Image size 2212x1659 · fundus photo · 45° field of view — 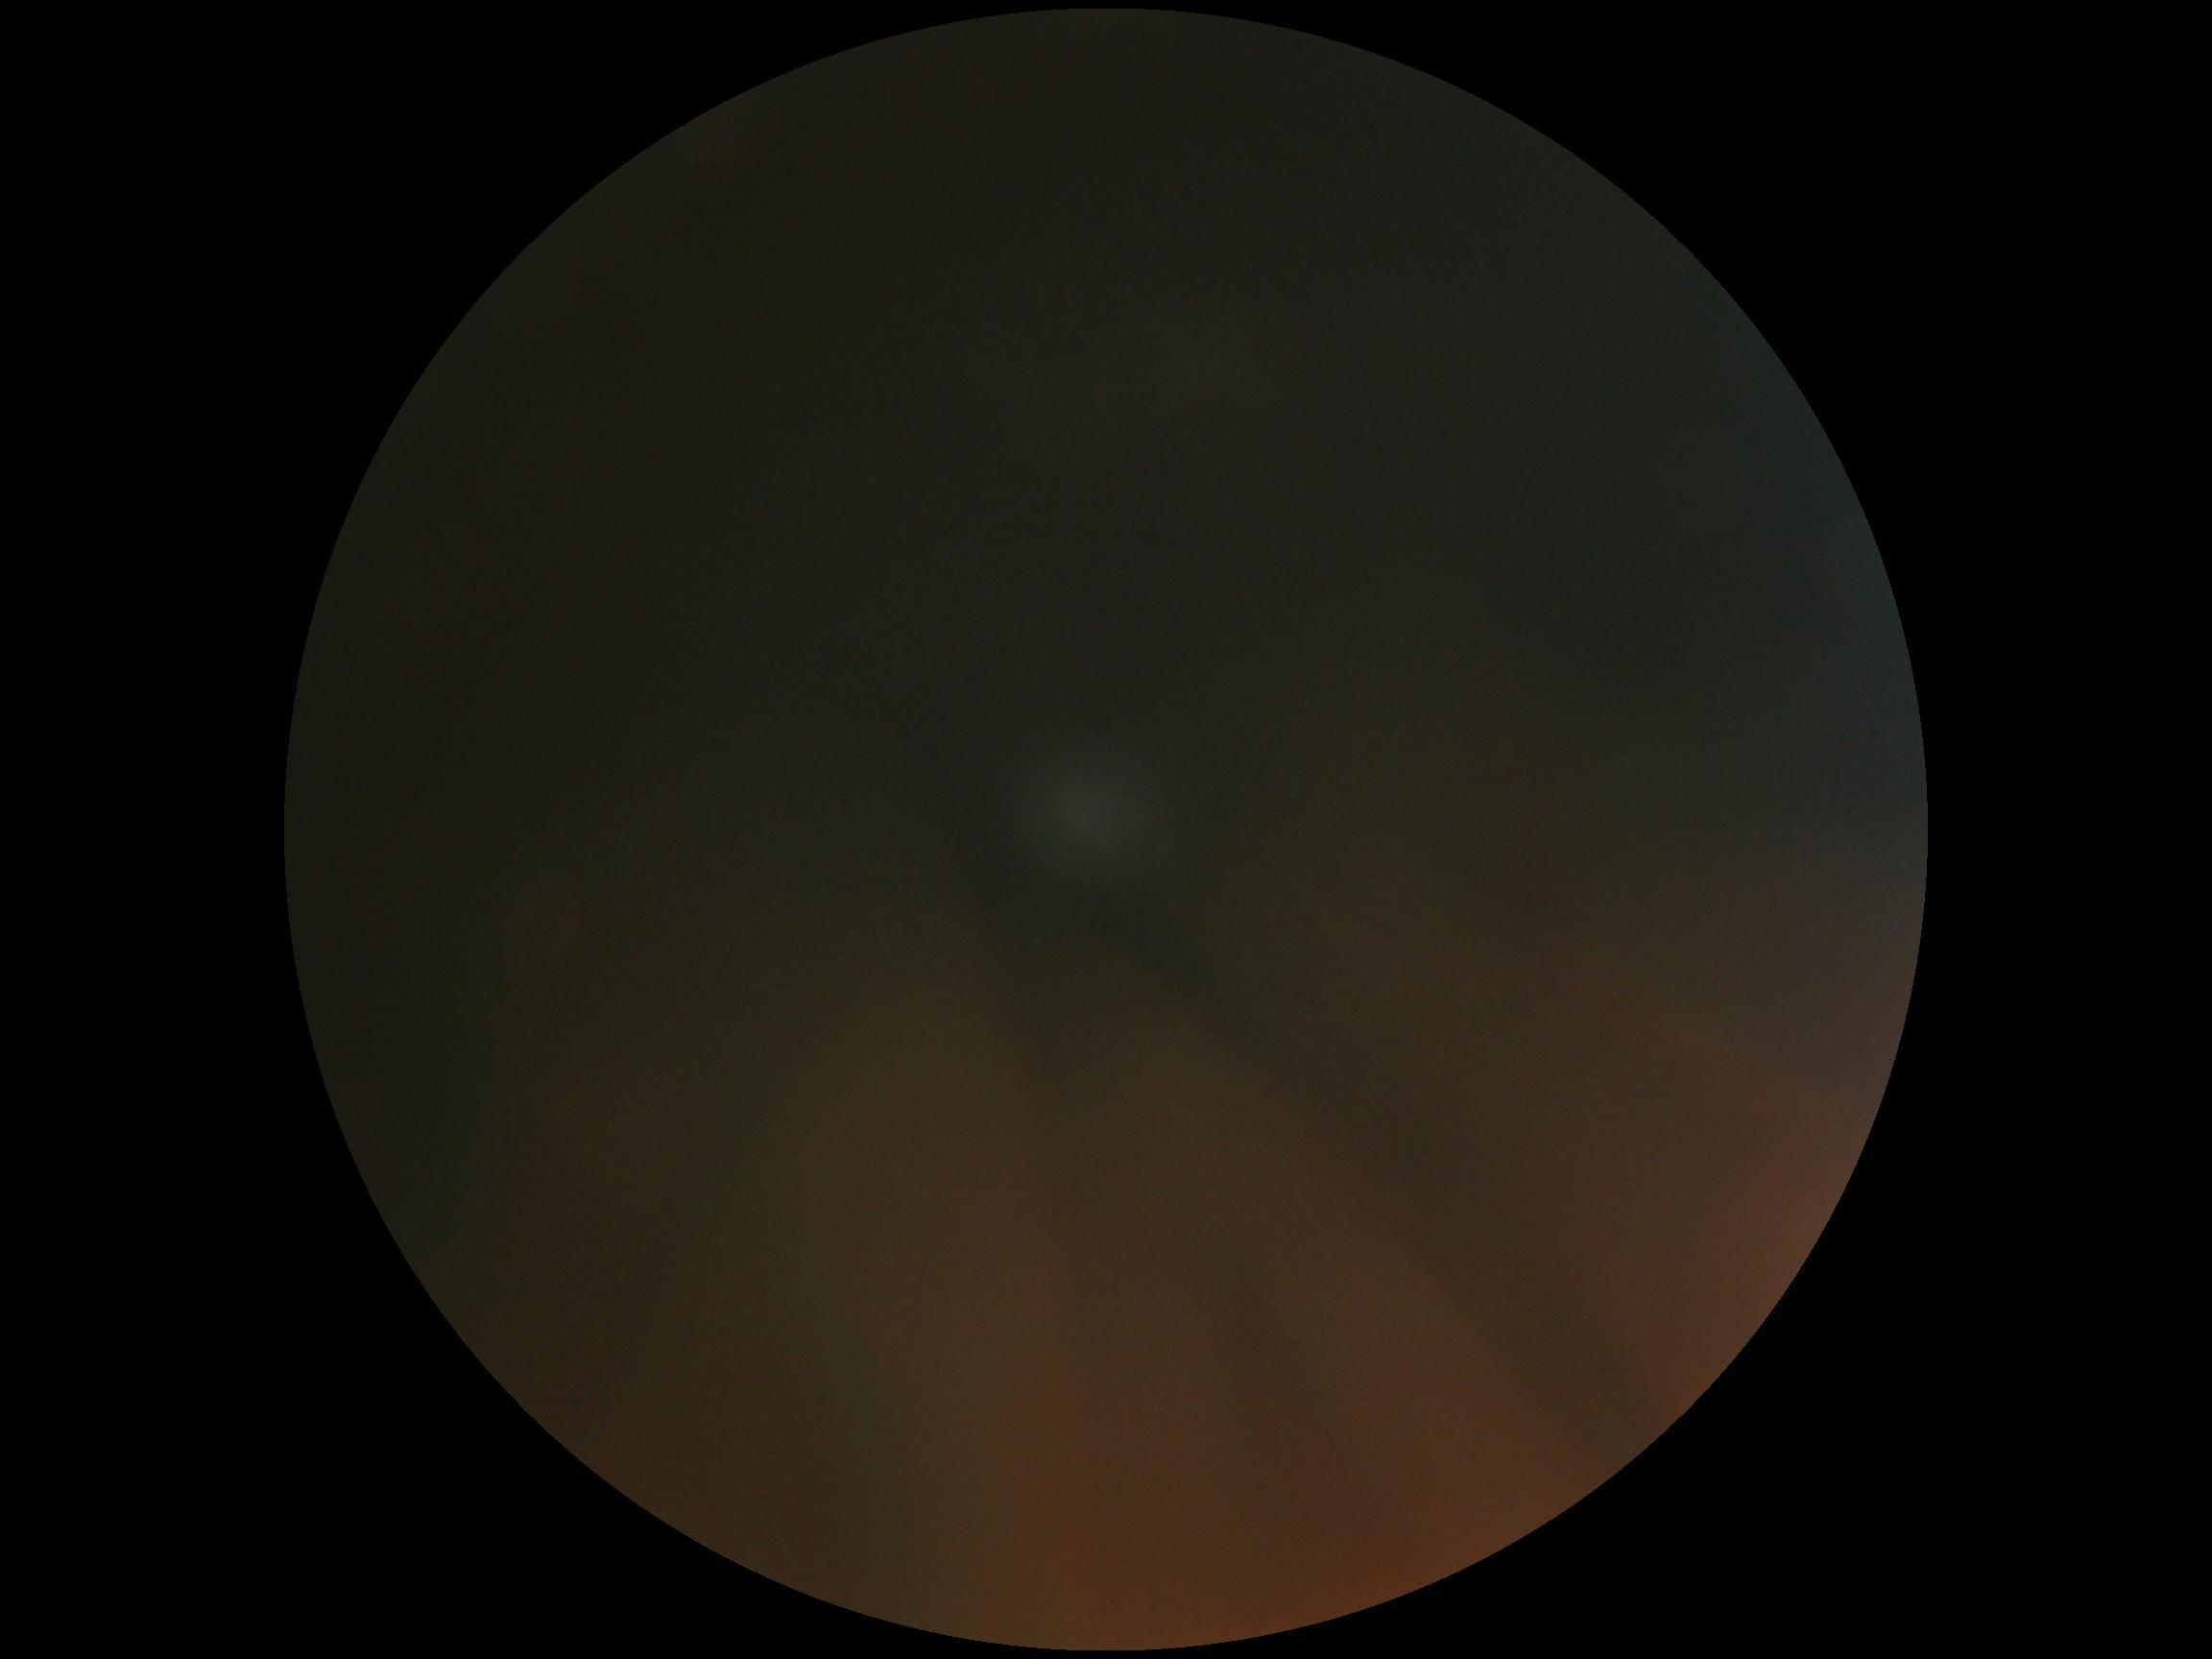

DR grade: ungradable due to poor image quality.